Infant wide-field fundus photograph · 640 x 480 pixels · captured with the Clarity RetCam 3 (130° field of view):
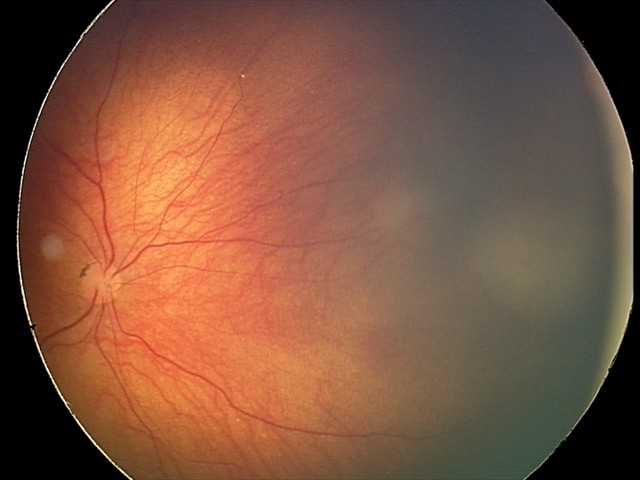

Diagnosis from this screening exam: retinal astrocytic hamartoma.